Pupil-dilated
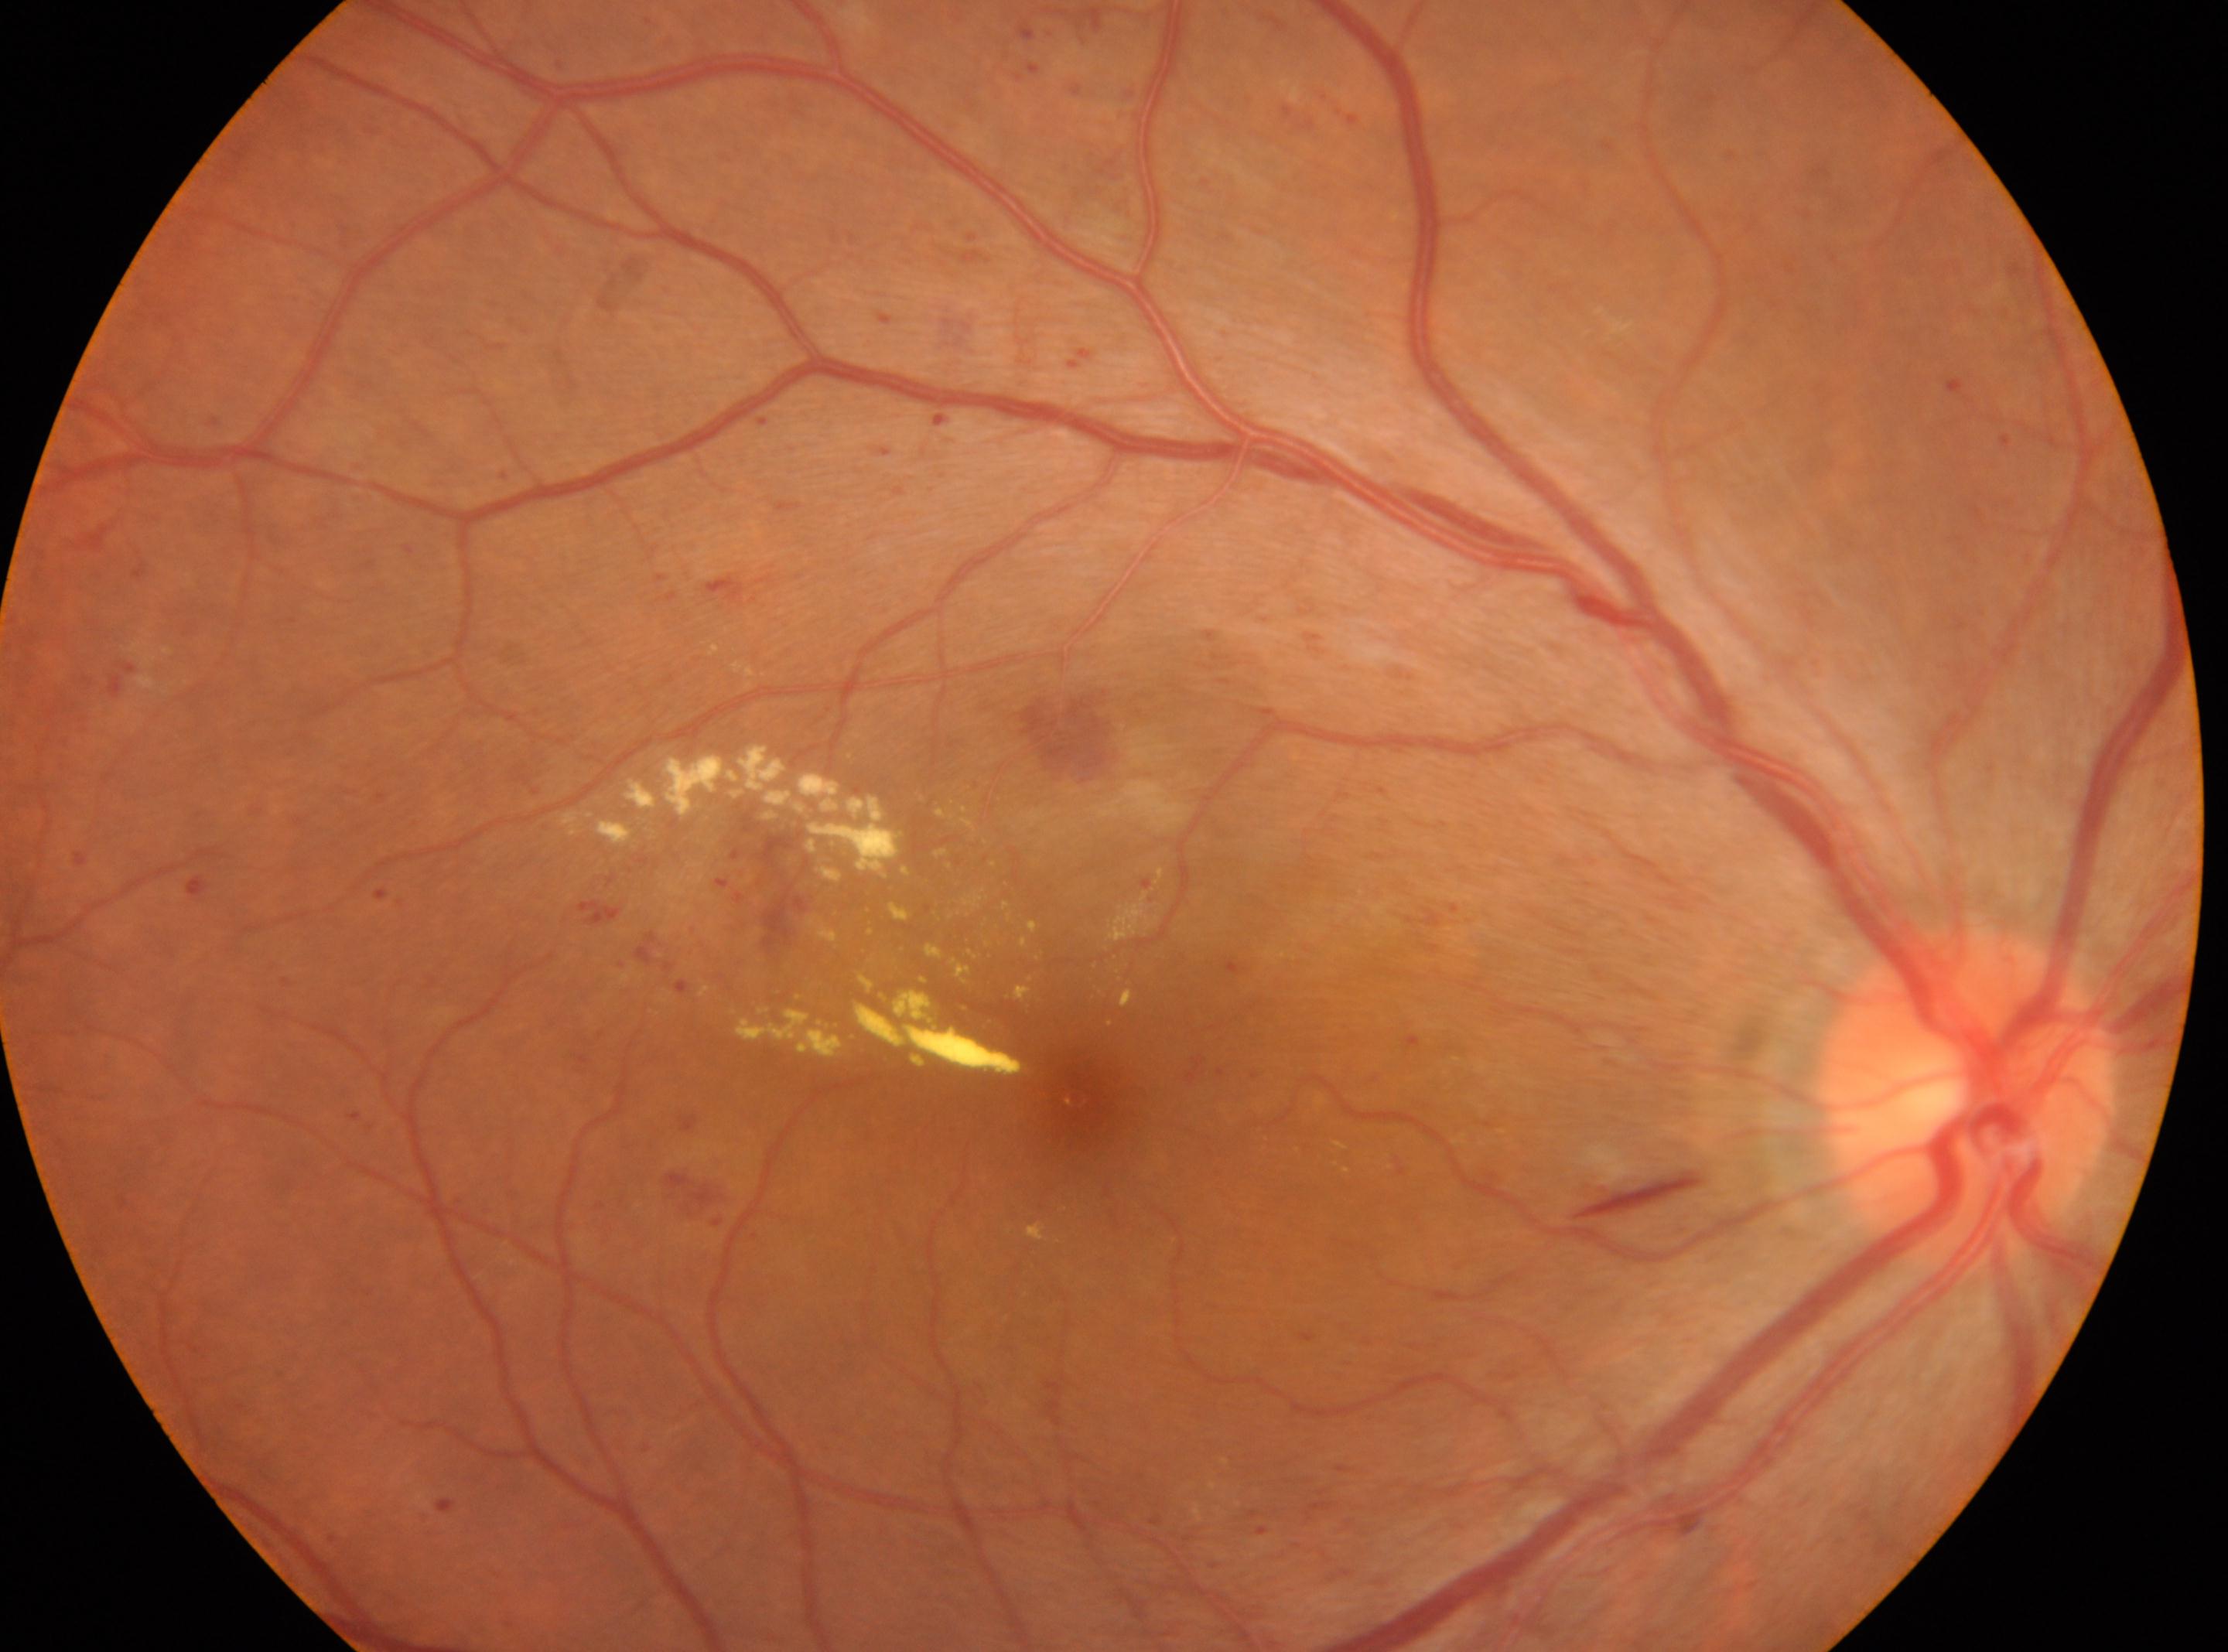 Findings:
• optic disc · (1966, 1098)
• DR class · non-proliferative diabetic retinopathy
• fovea · (1078, 1086)
• DR grade · moderate non-proliferative diabetic retinopathy (2)
• laterality · oculus dexter